640x480px; pediatric retinal photograph (wide-field); captured with the Clarity RetCam 3 (130° field of view): 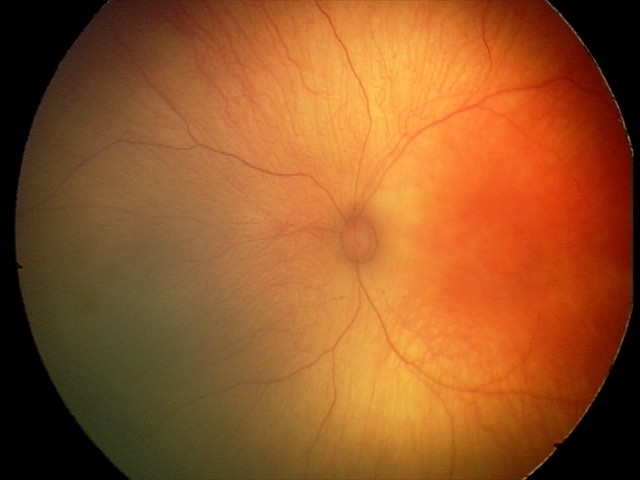
Screening examination with no abnormal retinal findings.